45° FOV; CFP.
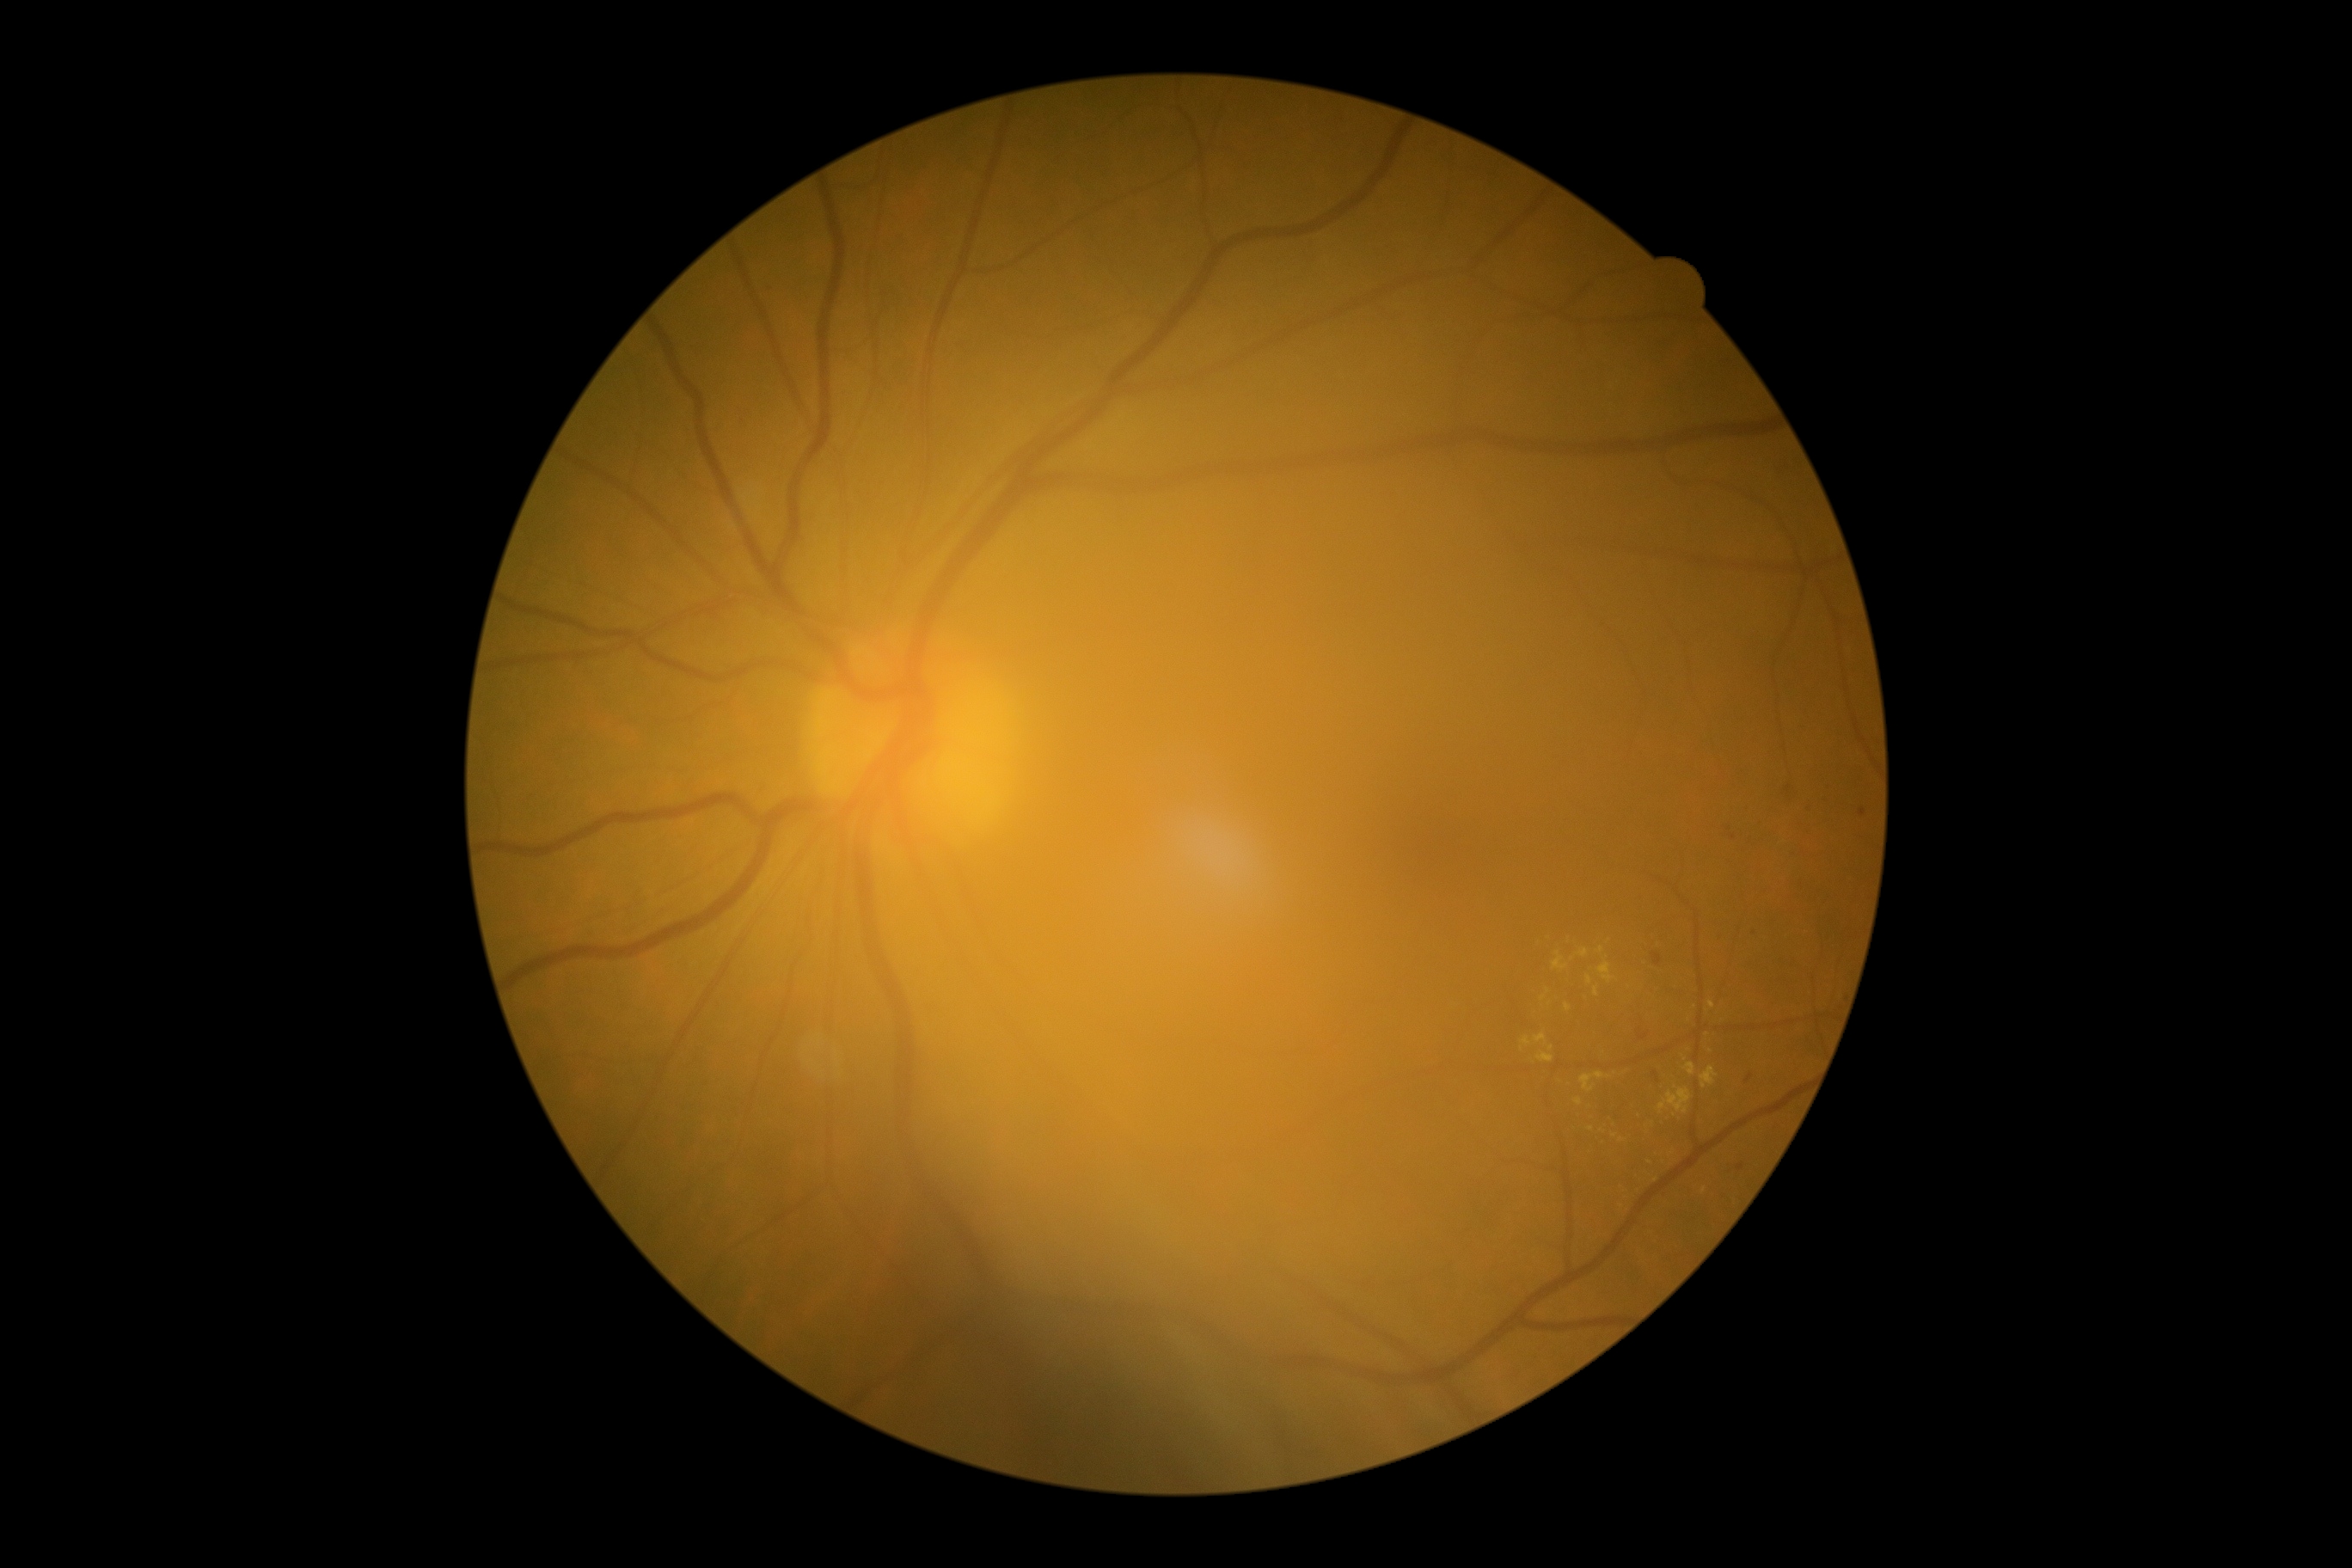
DR class=non-proliferative diabetic retinopathy; DR stage=2/4.